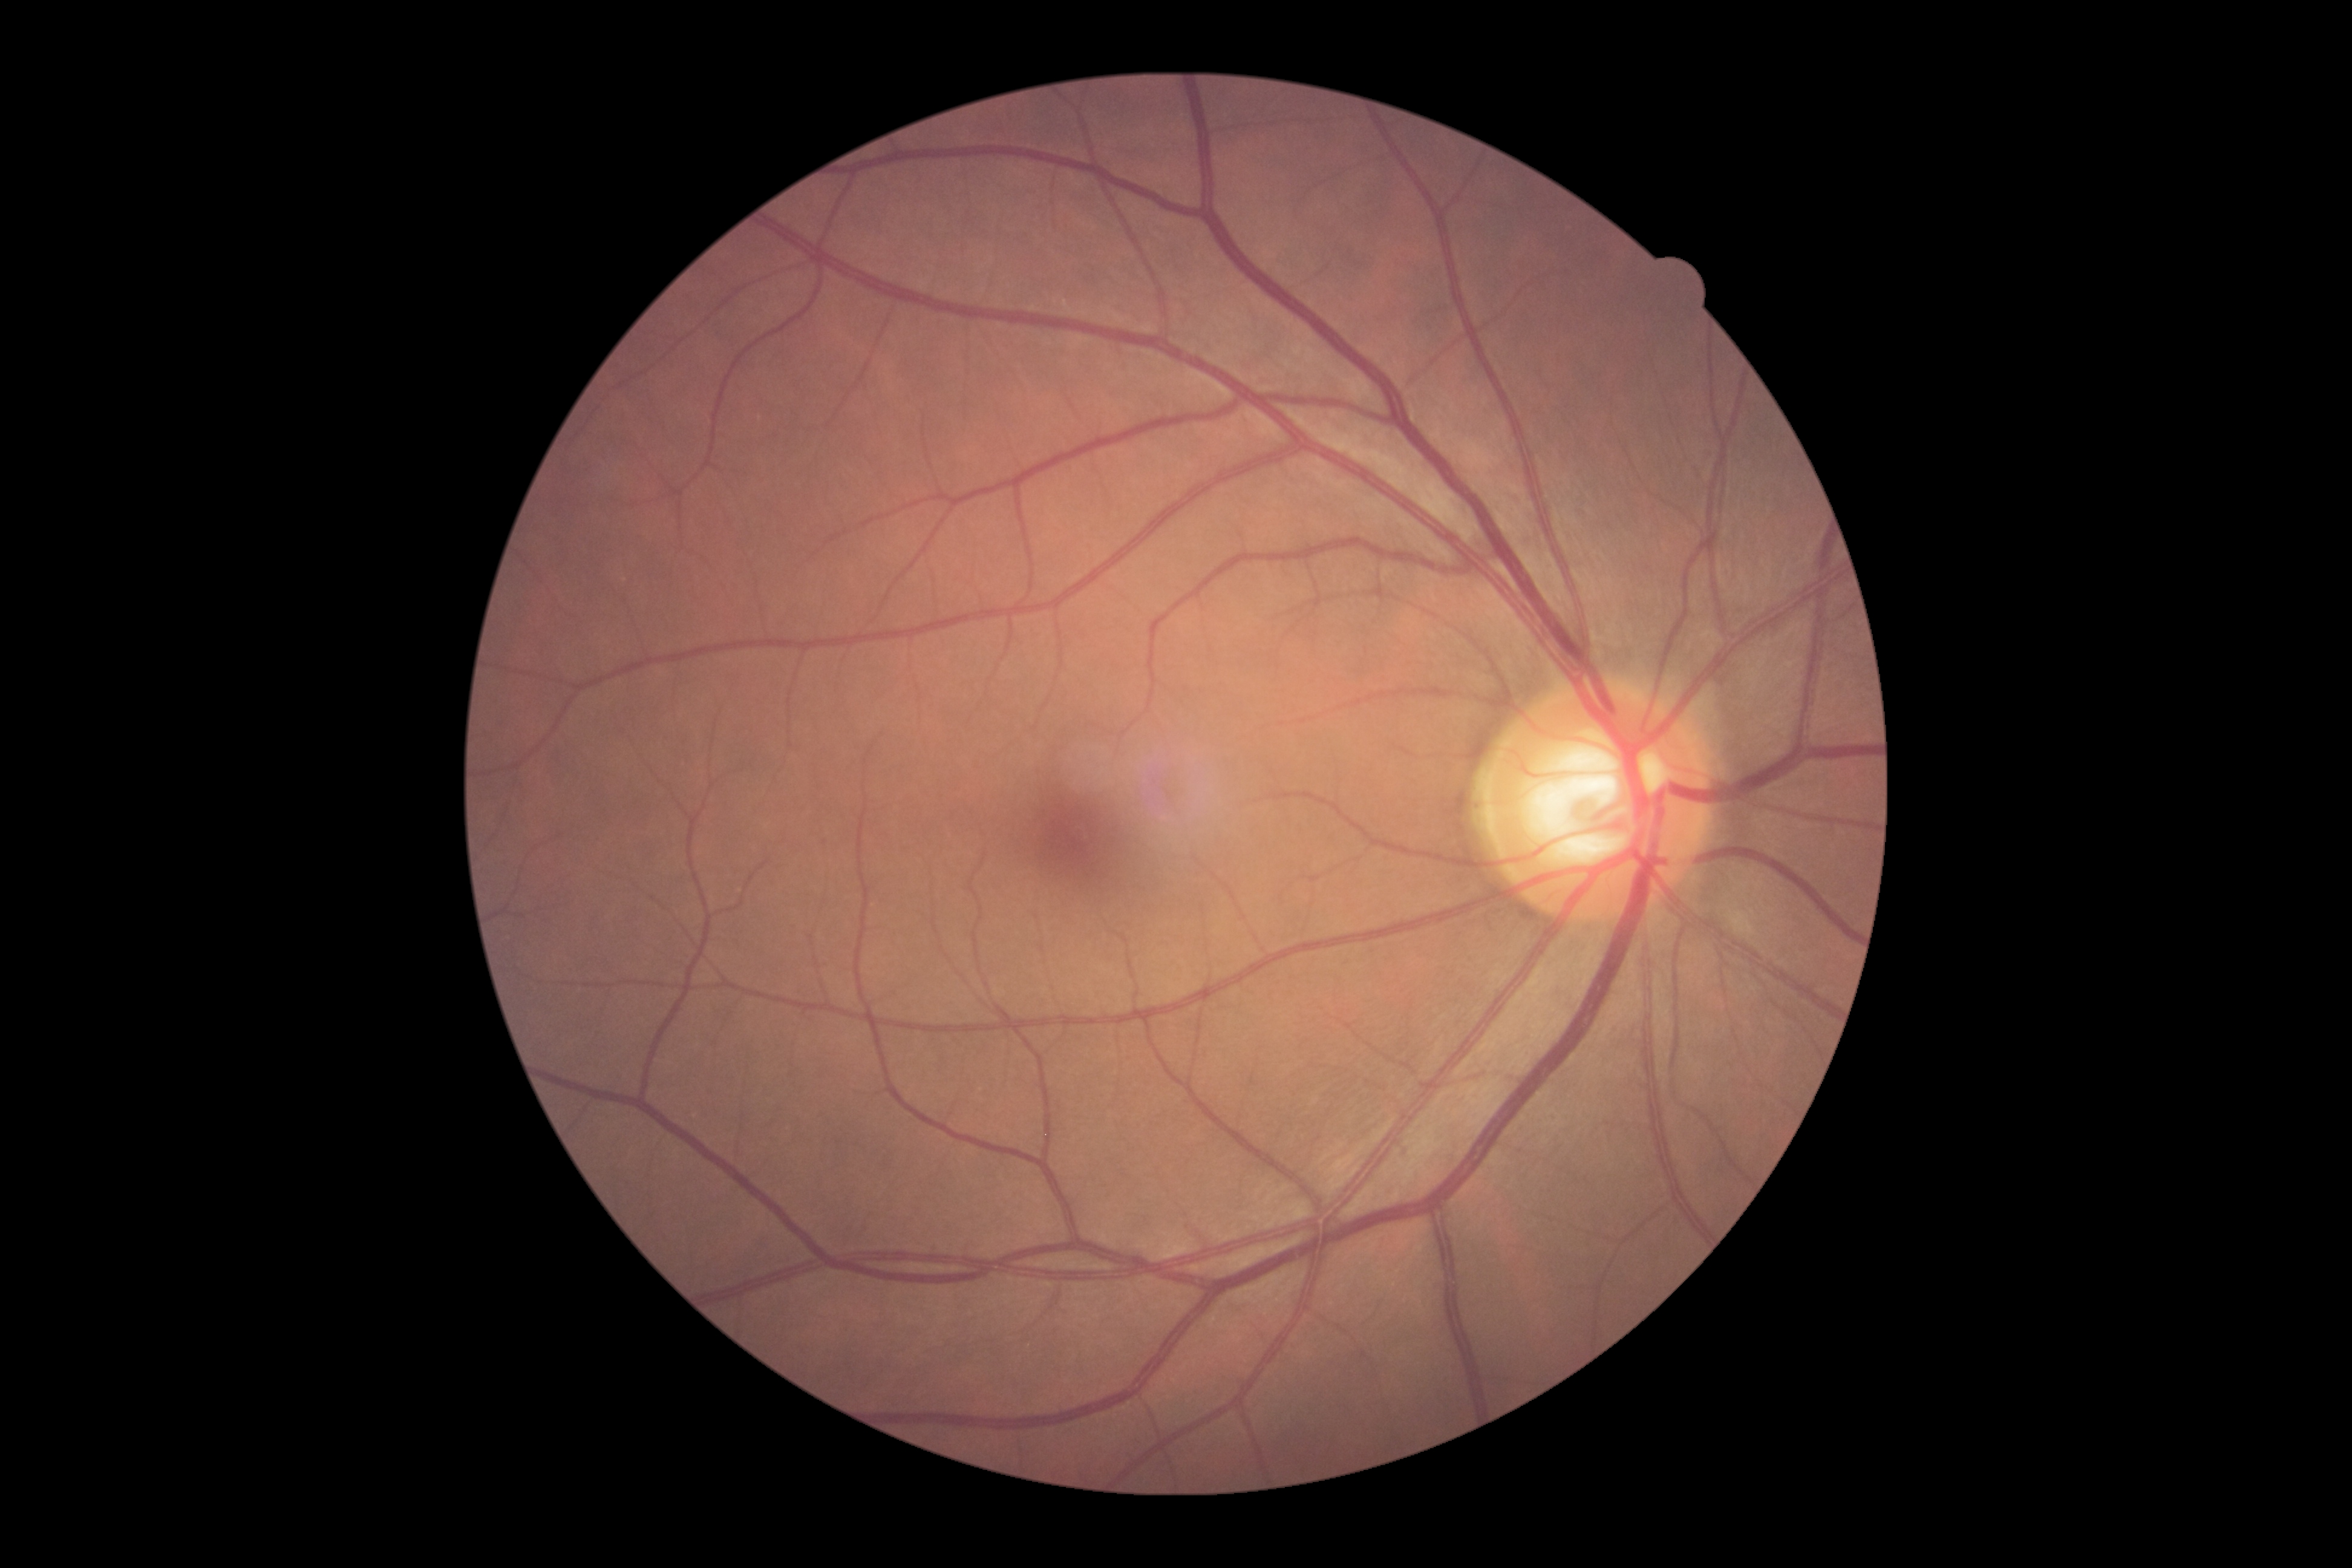 Diabetic retinopathy: grade 0 (no apparent retinopathy).